NIDEK AFC-230; 45 degree fundus photograph — 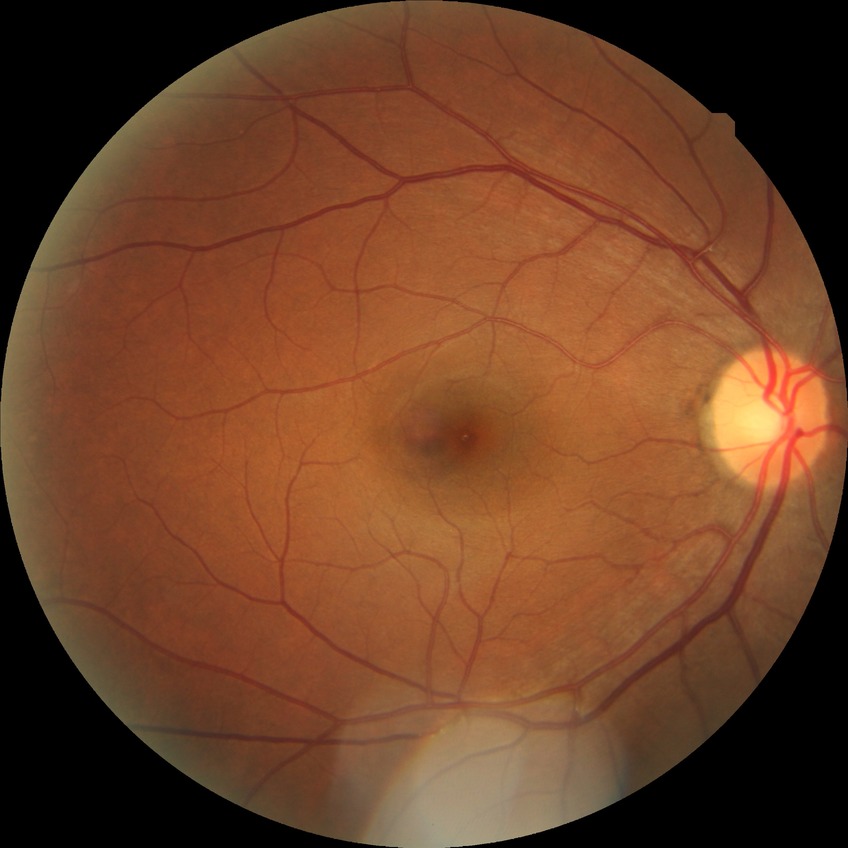 Davis grading: no diabetic retinopathy.